45-degree field of view; CFP; 2212 x 1659 pixels
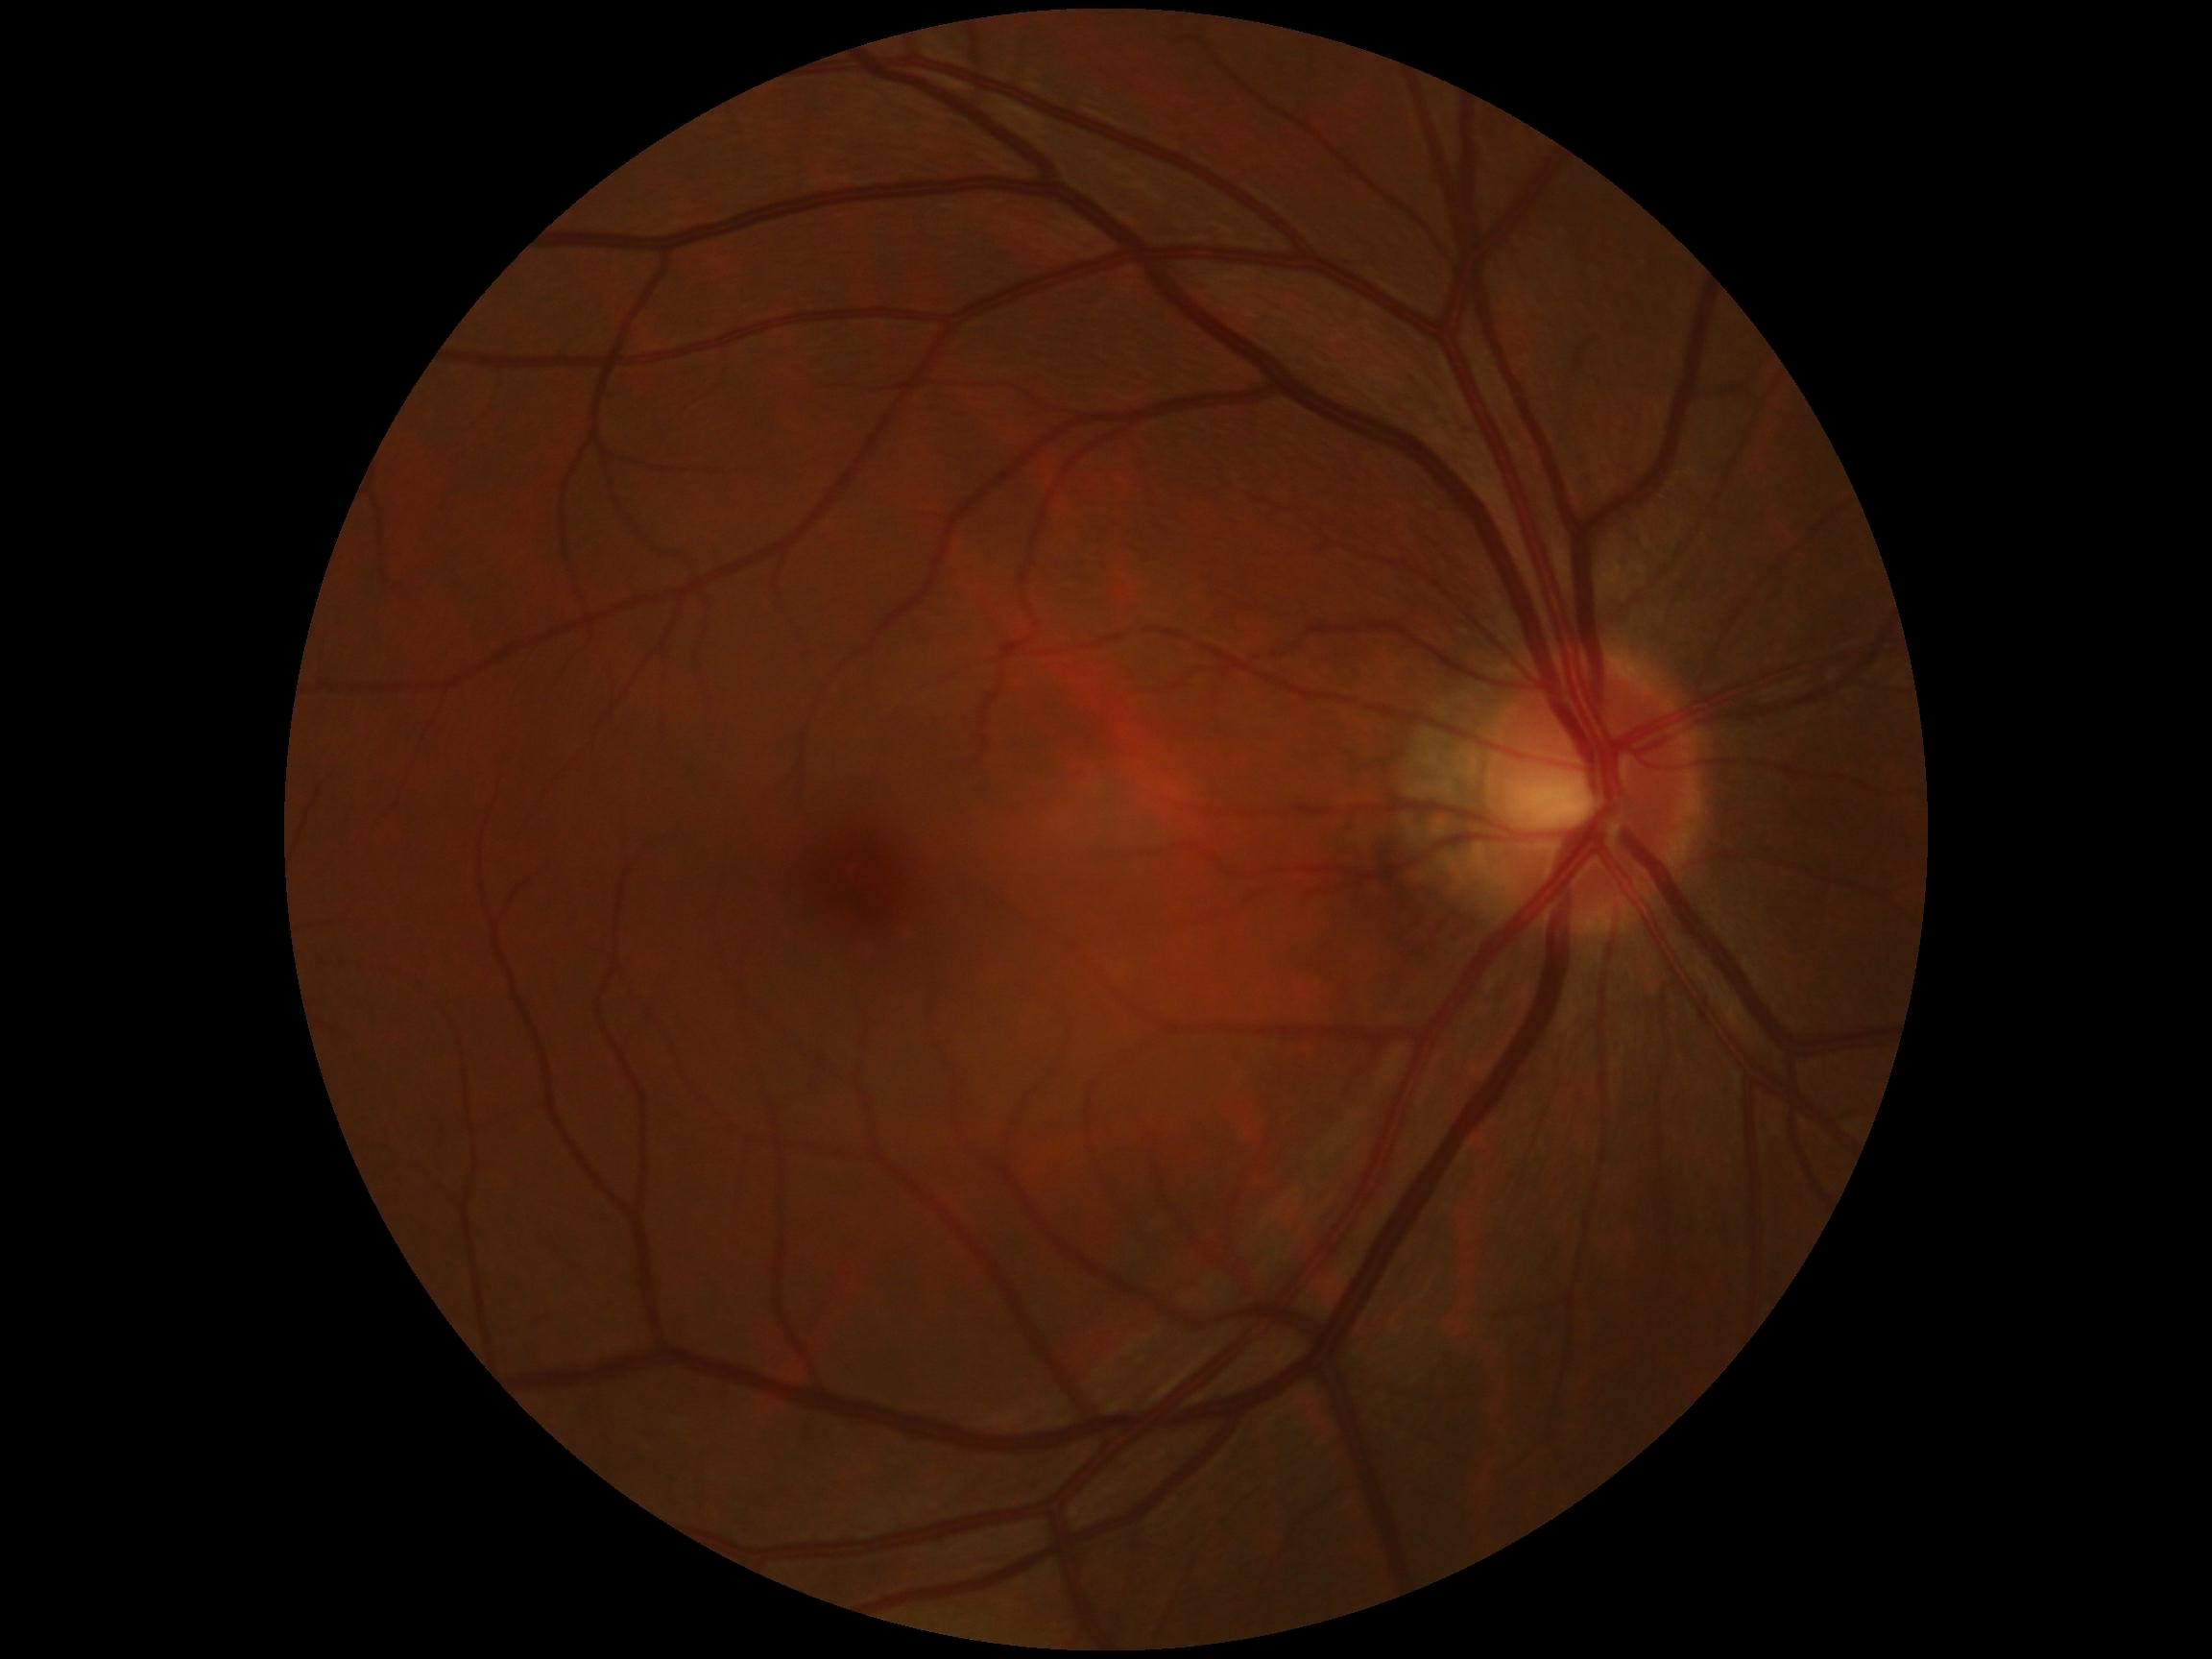

DR grade: 0 (no apparent retinopathy).